Infant wide-field retinal image:
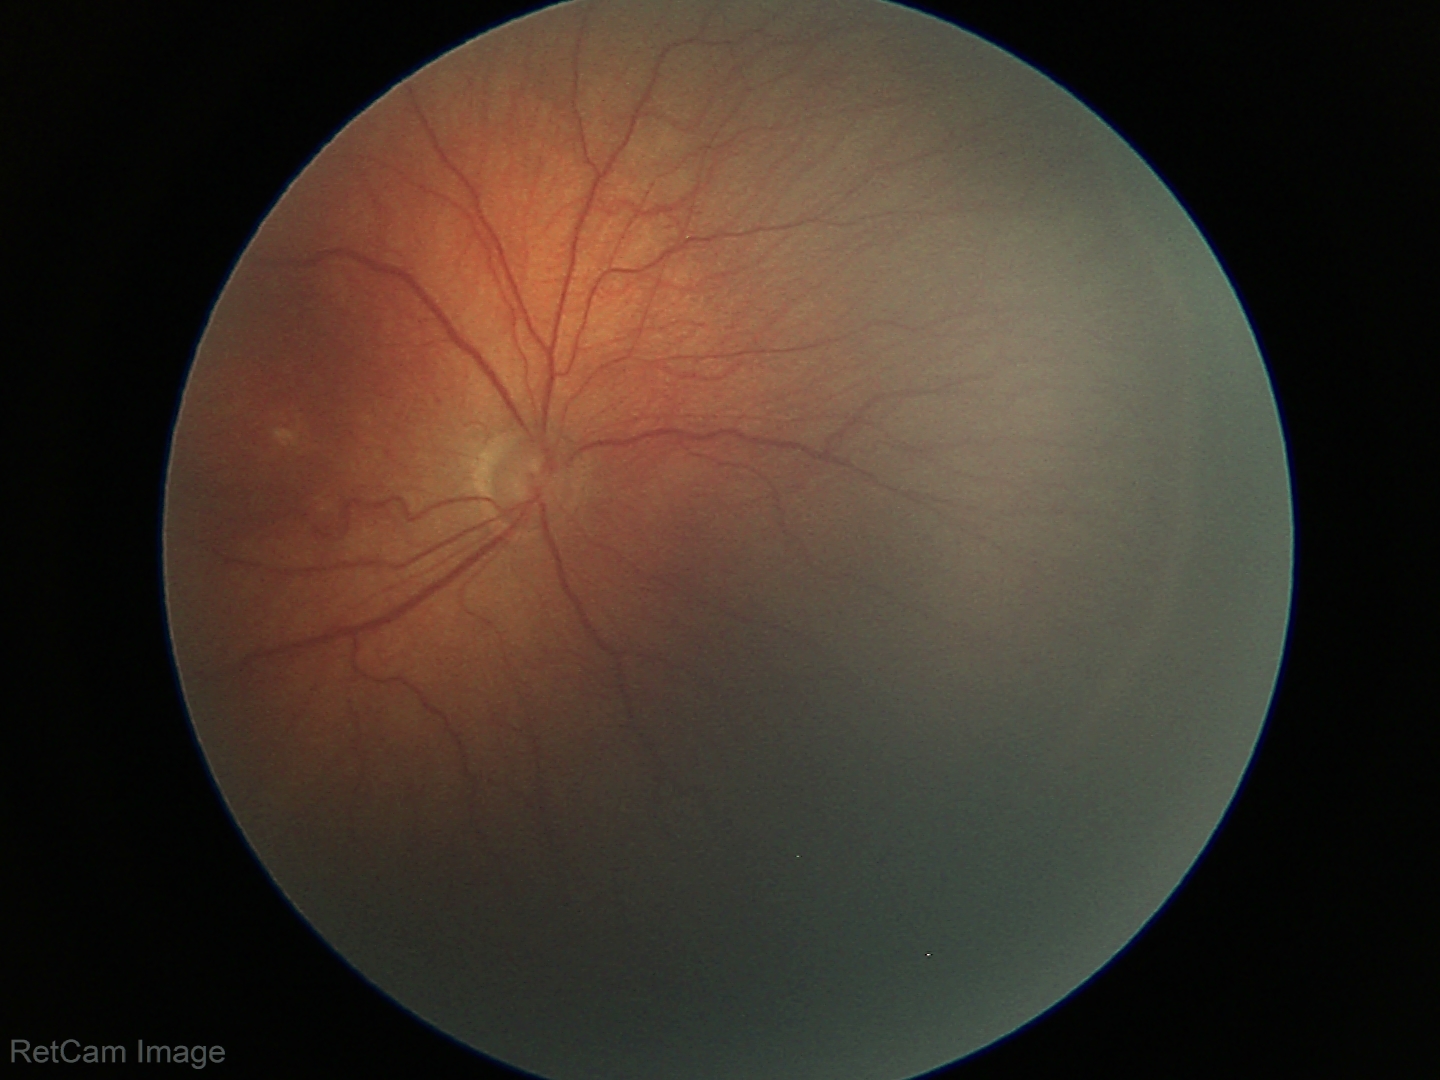

Q: What was the screening finding?
A: retinopathy of prematurity (ROP) stage 3